Infant wide-field retinal image. 1440x1080.
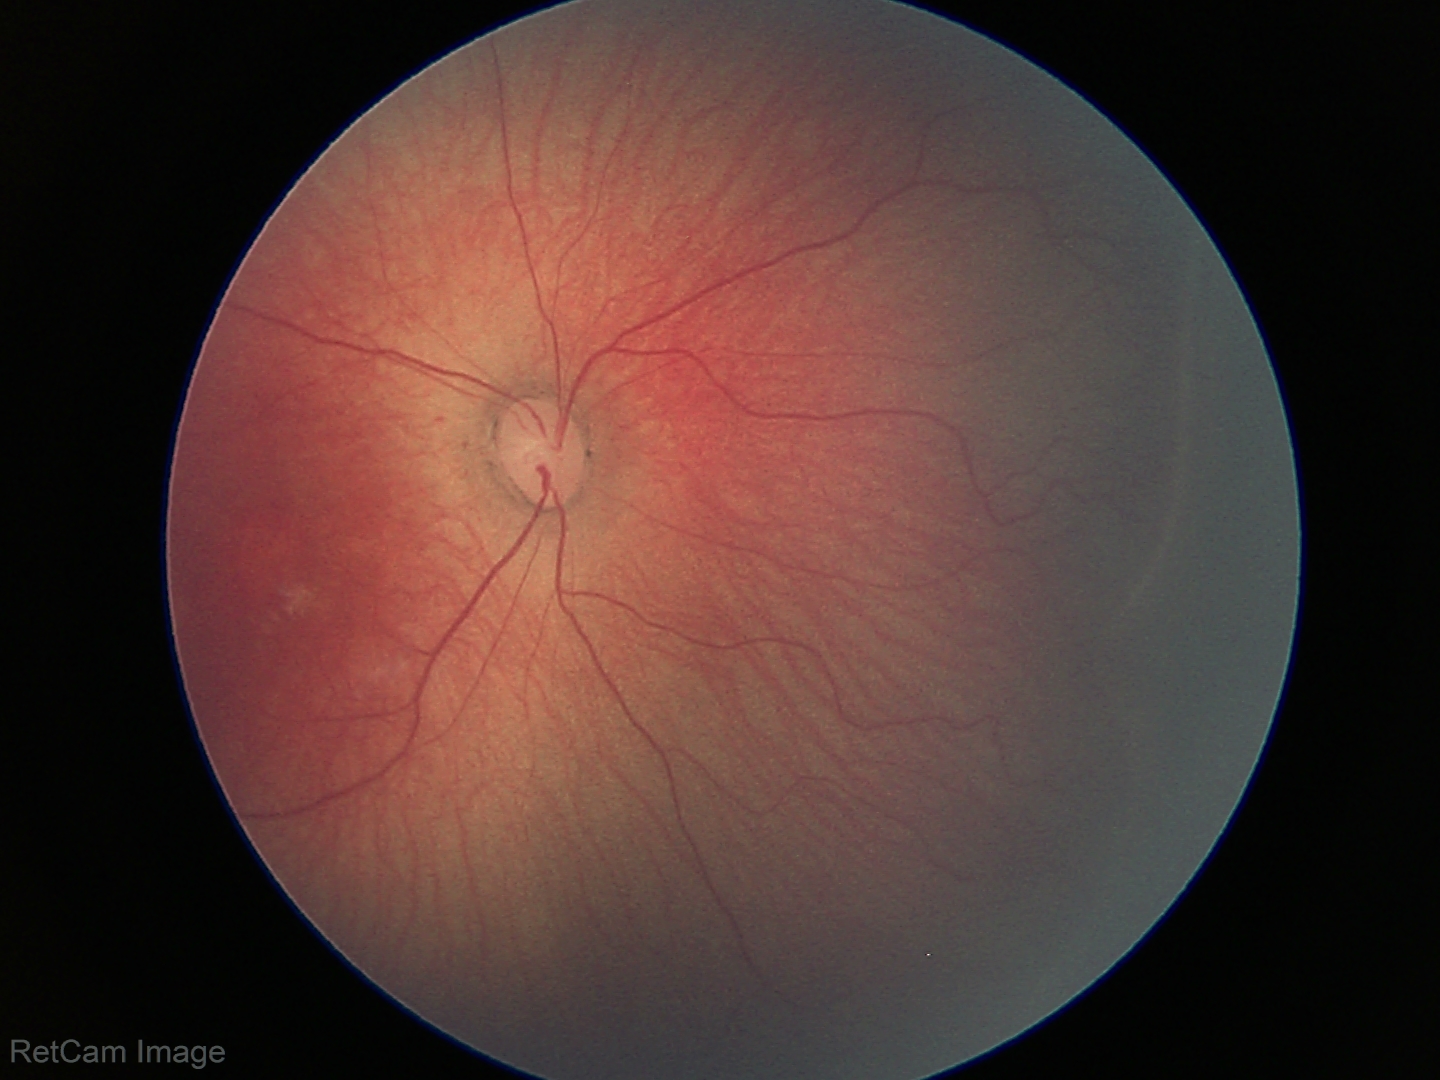

Screening series with retinopathy of prematurity stage 1. No plus disease.